Disc-centered field; non-mydriatic acquisition.
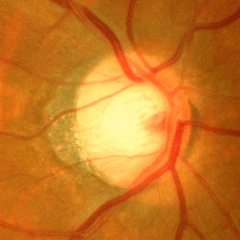
Q: Is glaucoma present?
A: Advanced glaucomatous optic neuropathy.